1440x1080; wide-field fundus photograph from neonatal ROP screening; 130° field of view (Natus RetCam Envision).
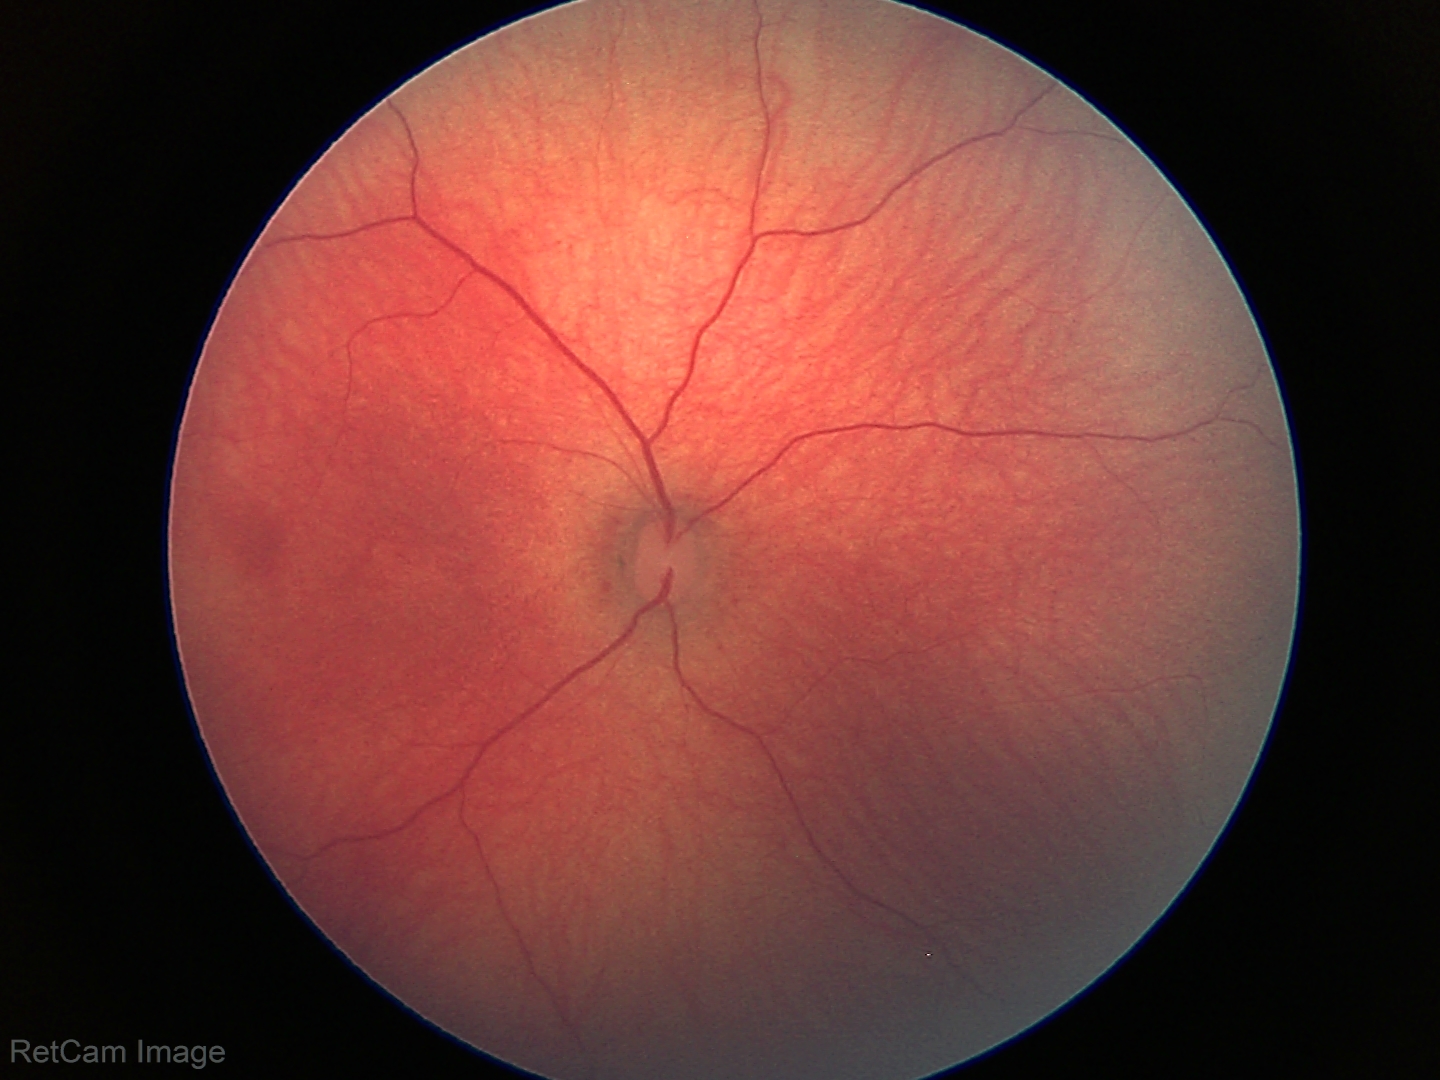 Physiological retinal appearance for postconceptual age.